Camera: Nidek AFC-330, 240x240, color fundus image
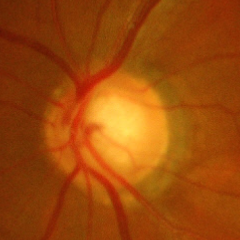

Showing severe glaucomatous damage.